Davis DR grading · nonmydriatic fundus photograph
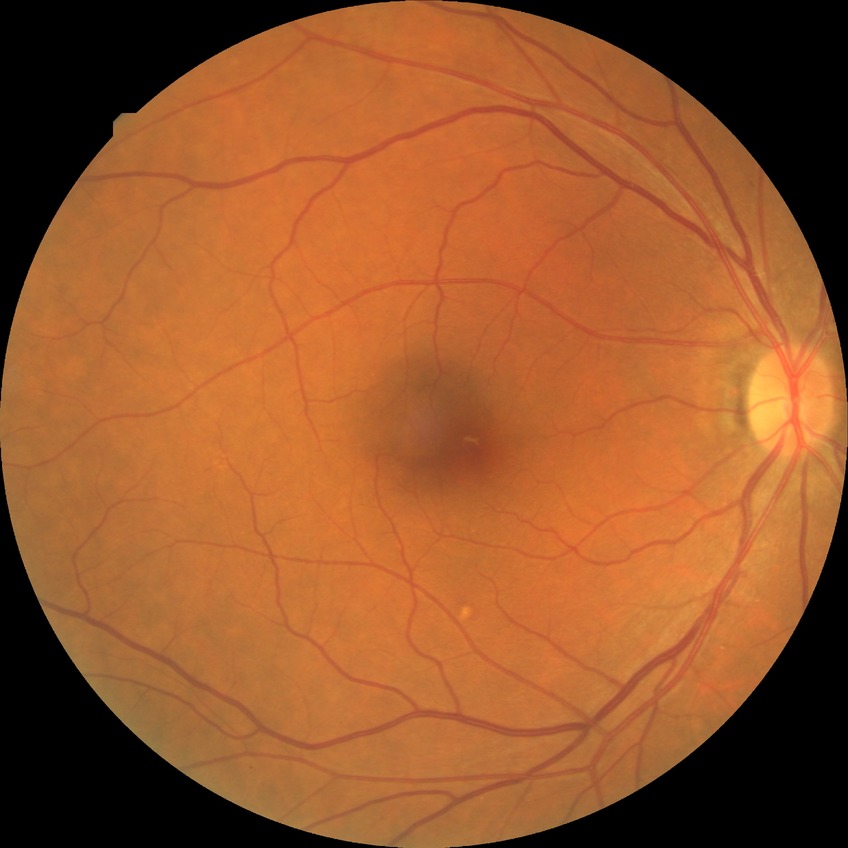

Diabetic retinopathy (DR) is NDR (no diabetic retinopathy).